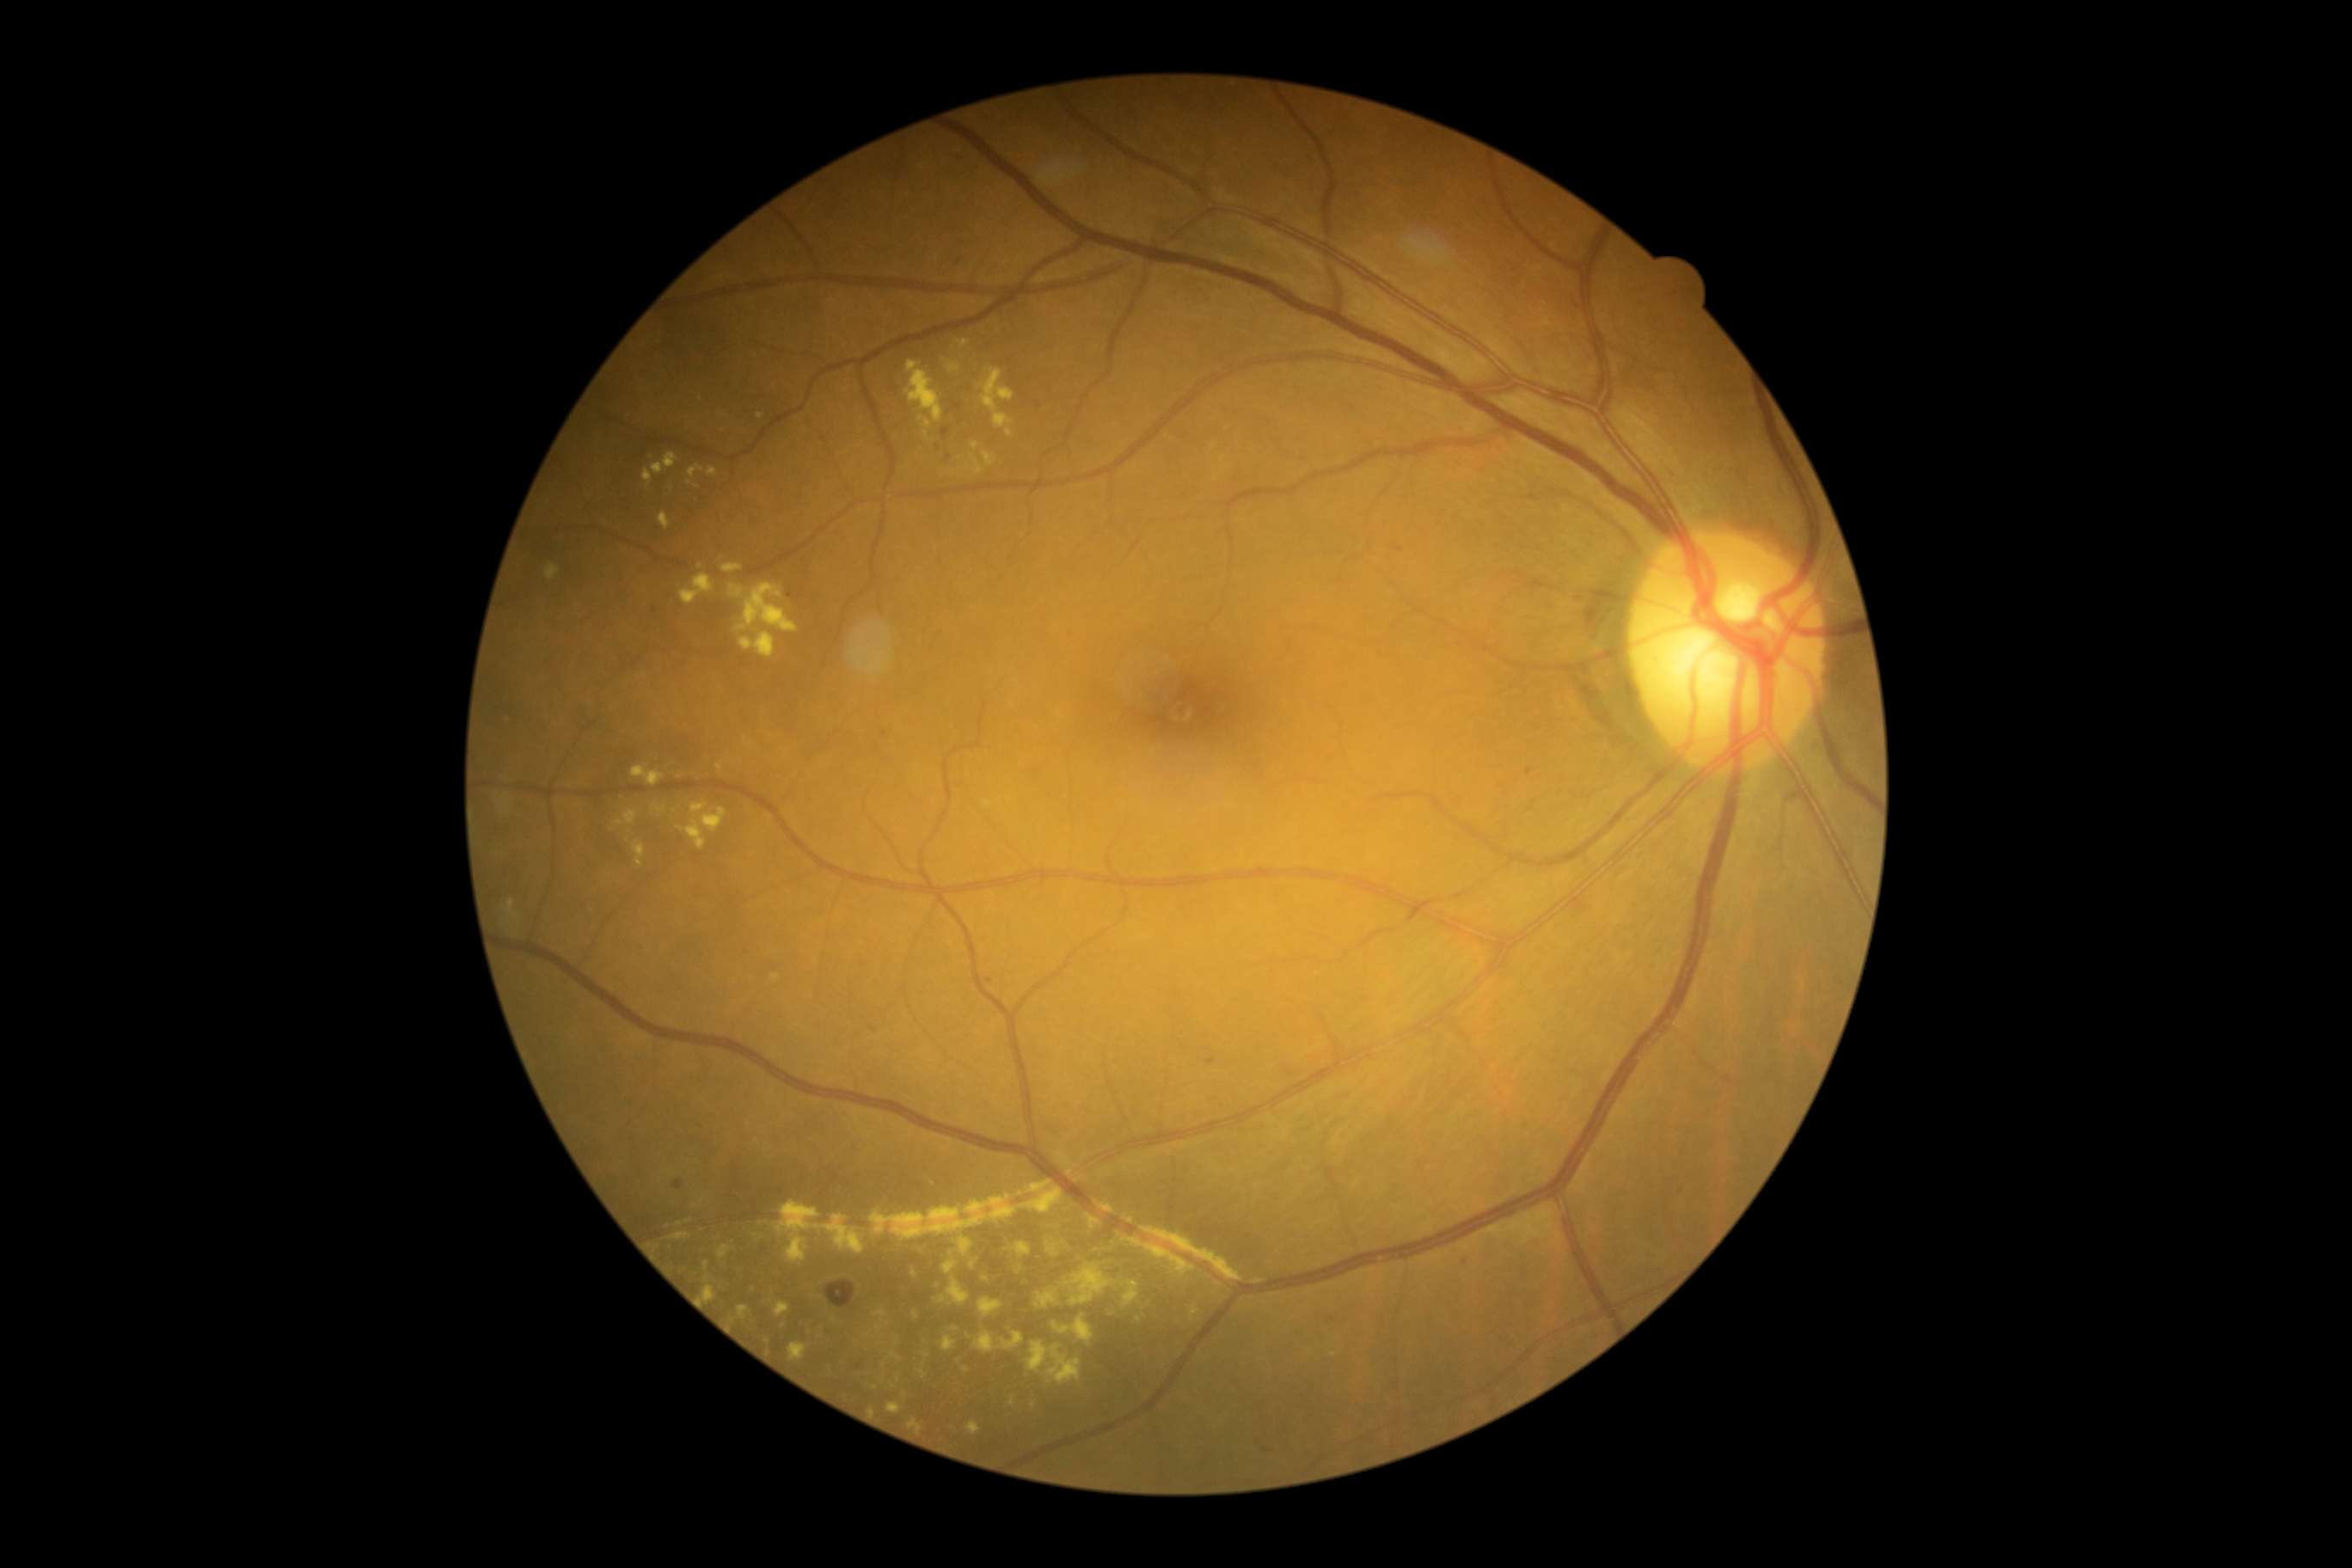 DR grade is 2
Representative lesions:
EXs (continued): 775/1302/792/1318 | 728/585/745/599 | 977/1297/1003/1318 | 632/842/646/867 | 984/453/996/467 | 974/1332/1026/1354 | 690/804/709/814 | 1027/1340/1081/1385 | 1543/321/1552/328 | 864/1332/873/1338 | 716/764/725/773 | 771/974/781/984
Small EXs near [1222,459] | [1543,312] | [871,1409] | [733,1319] | [656,1248] | [905,1395] | [1034,1406]